Color fundus photograph; 45-degree field of view; 2212x1659.
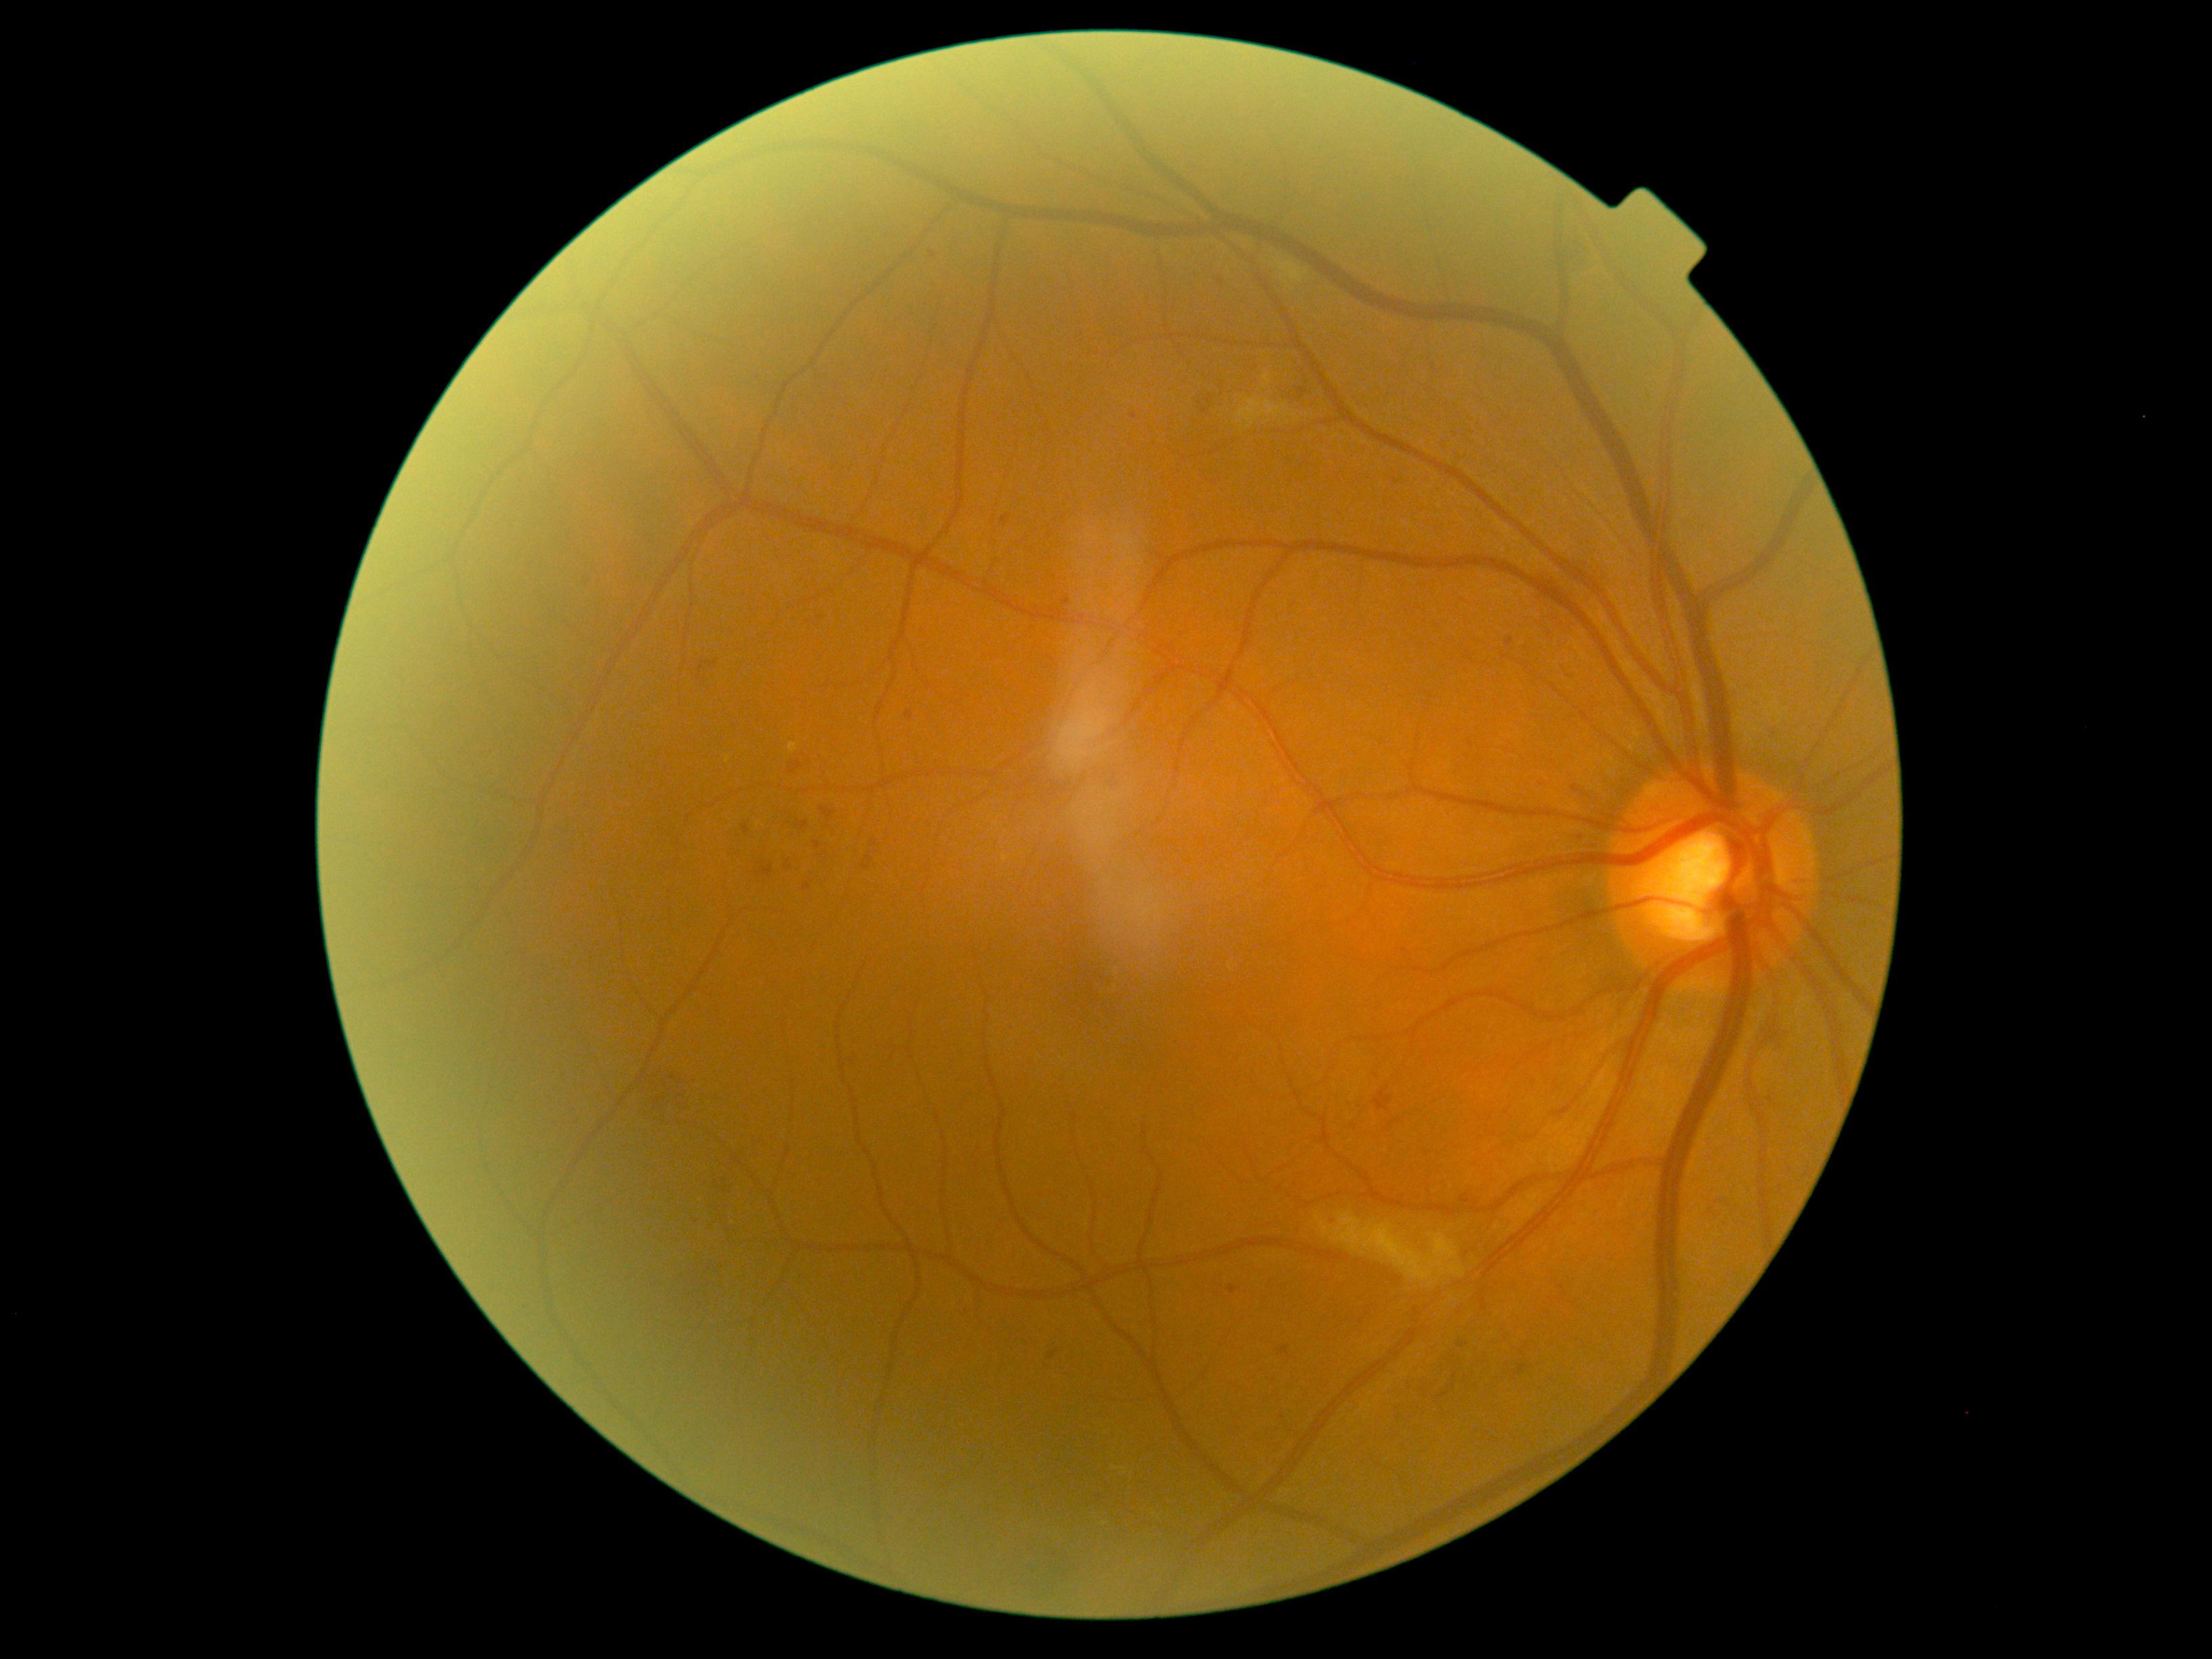 DR grade is 2/4.